FOV: 45 degrees.
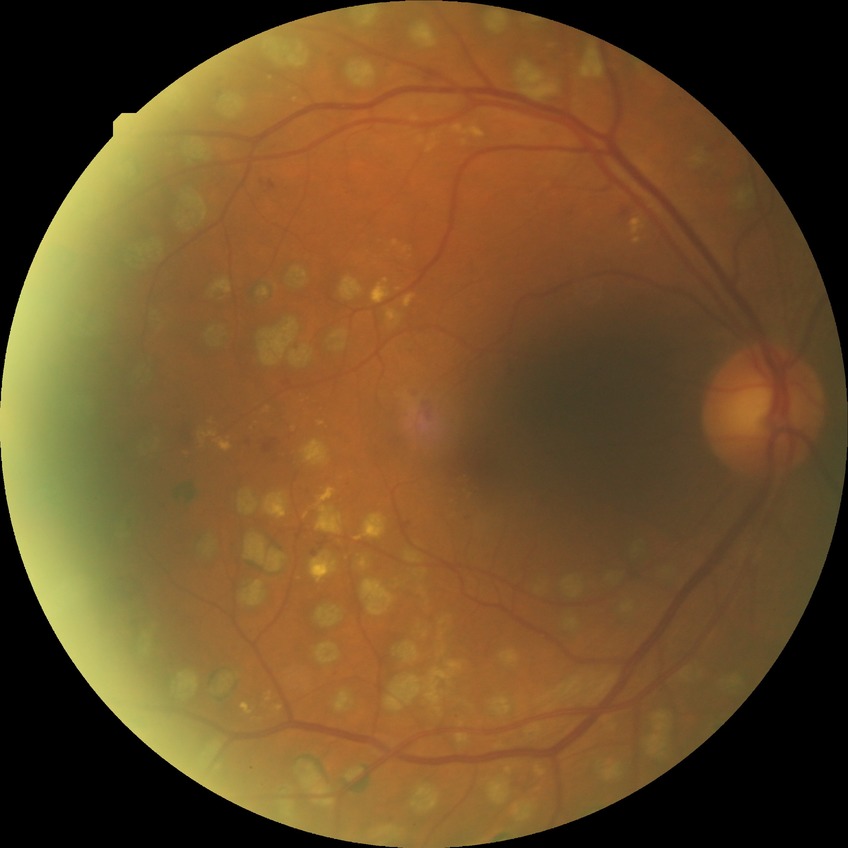

Diabetic retinopathy (DR): proliferative diabetic retinopathy (PDR).